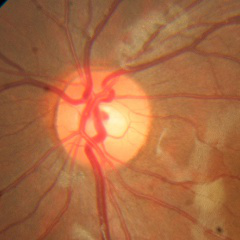 Glaucoma status = no glaucomatous optic neuropathy.